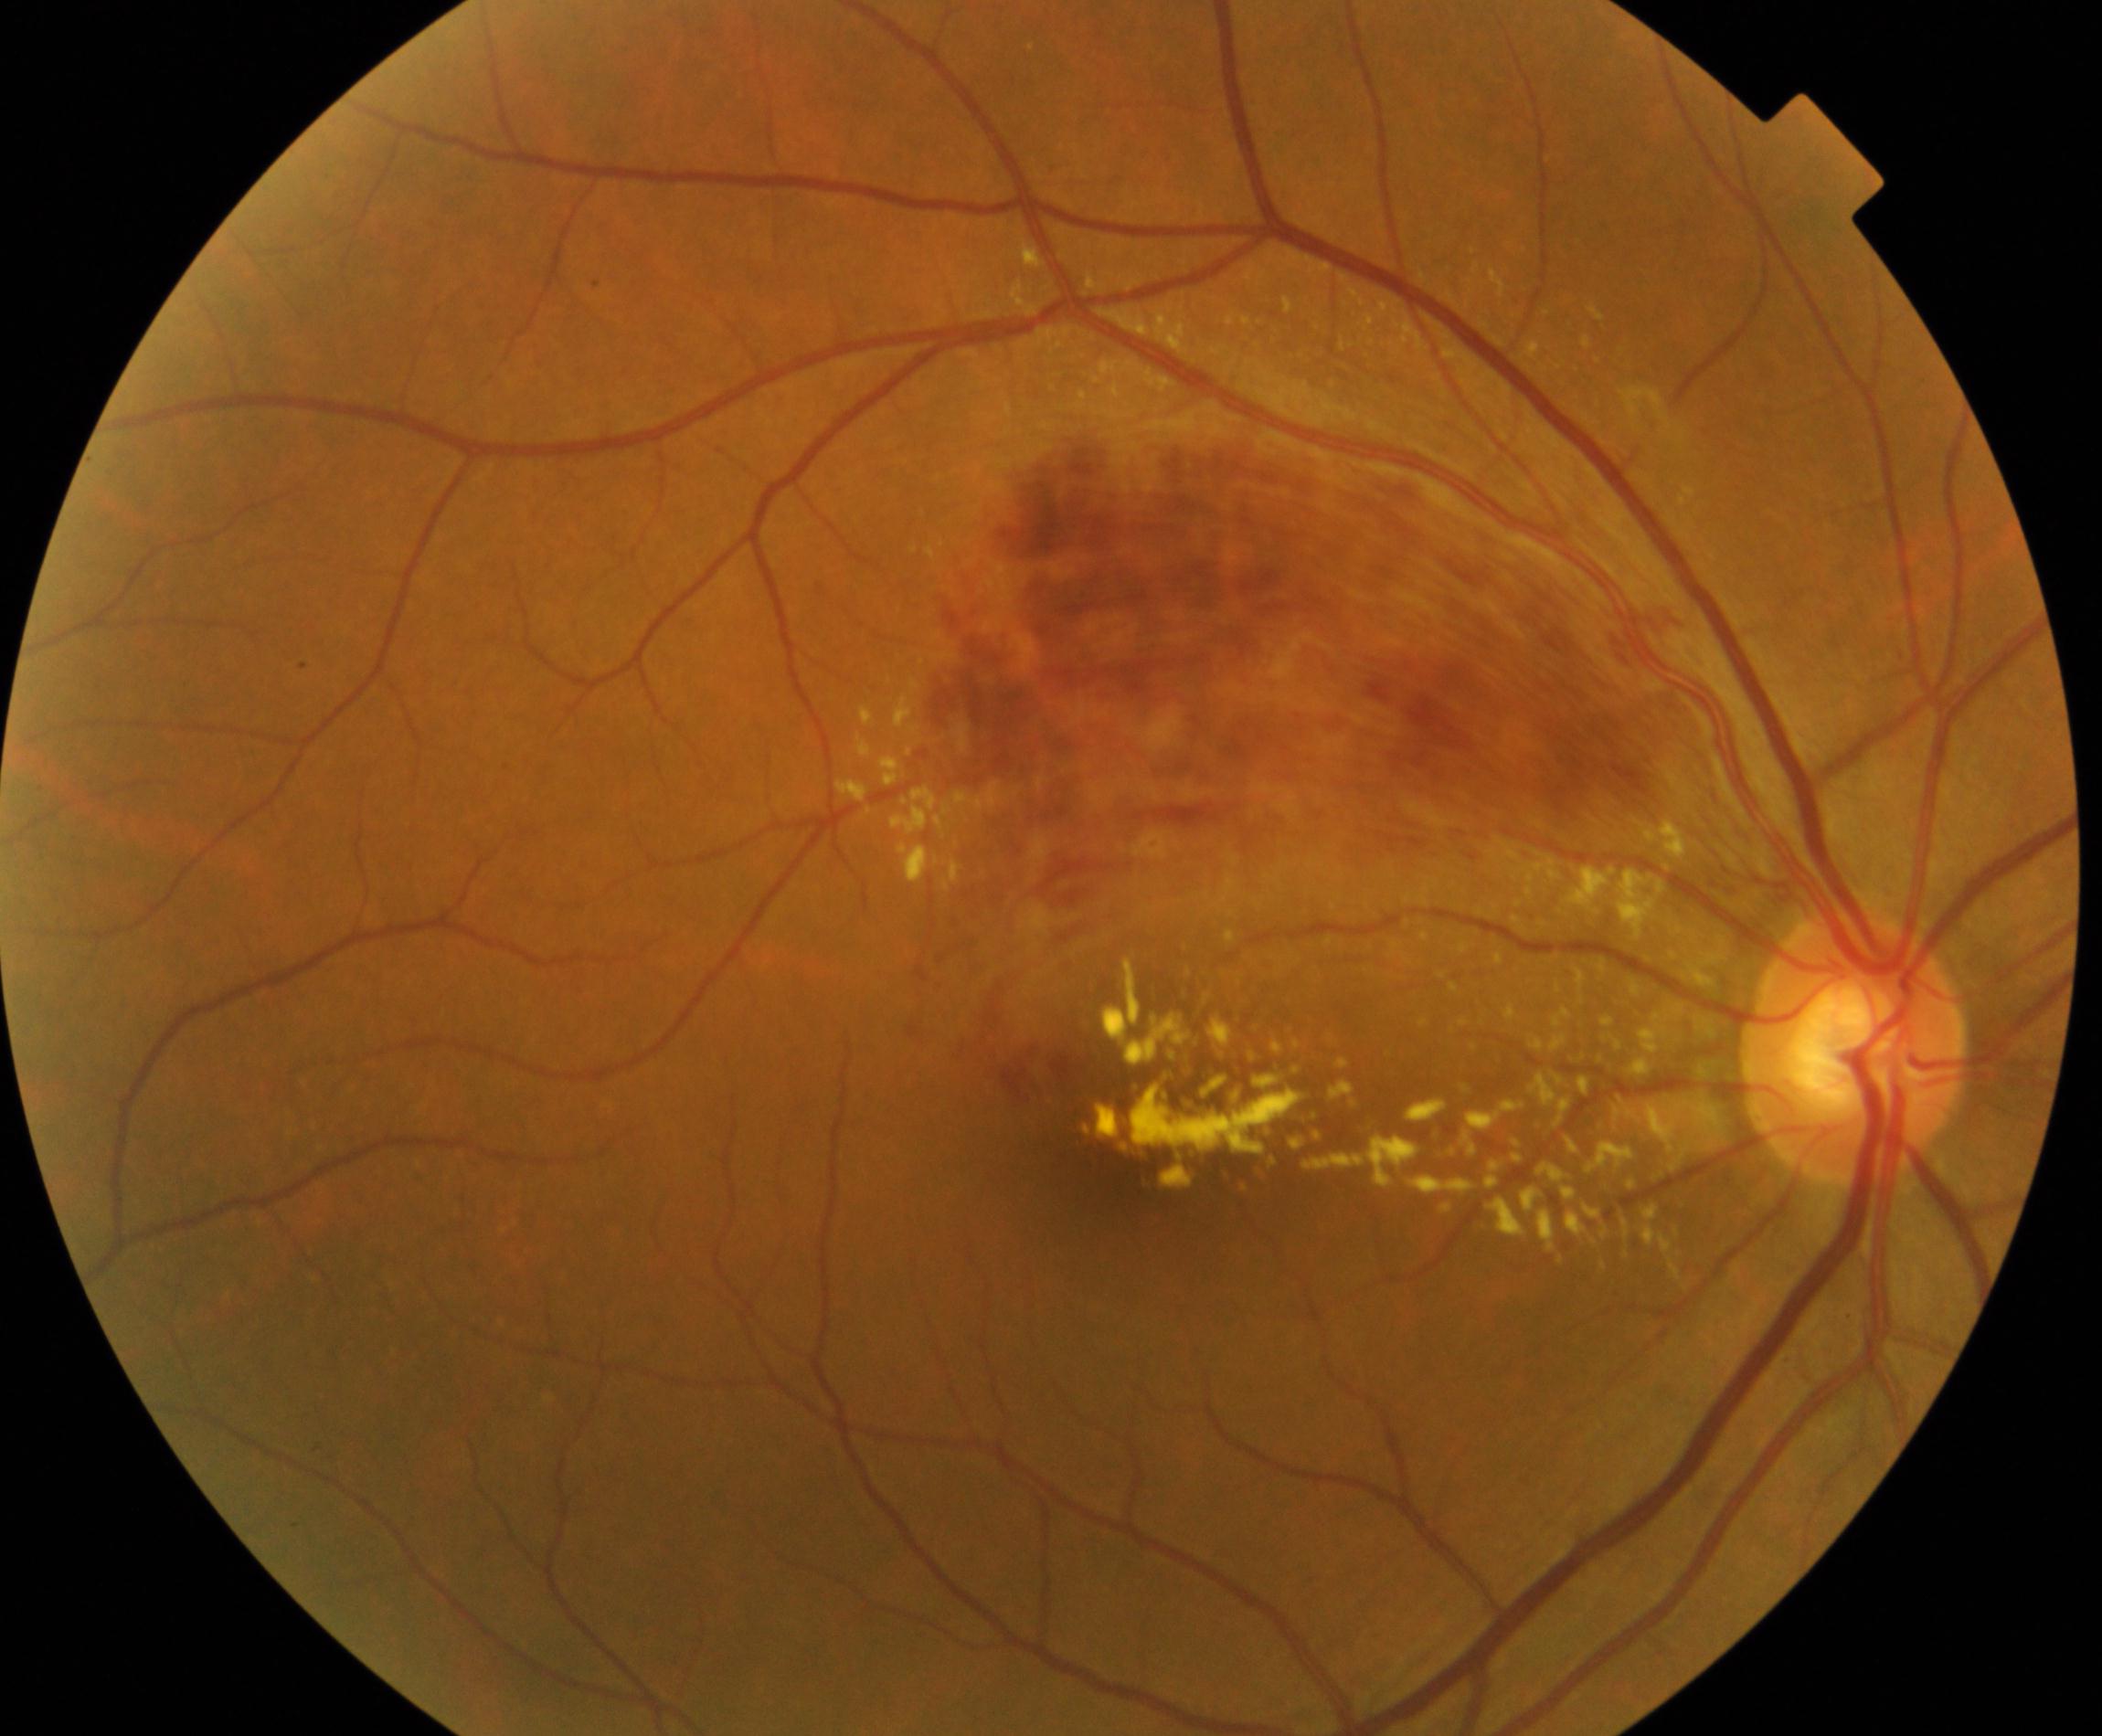
Fundus appearance consistent with branch retinal vein occlusion.